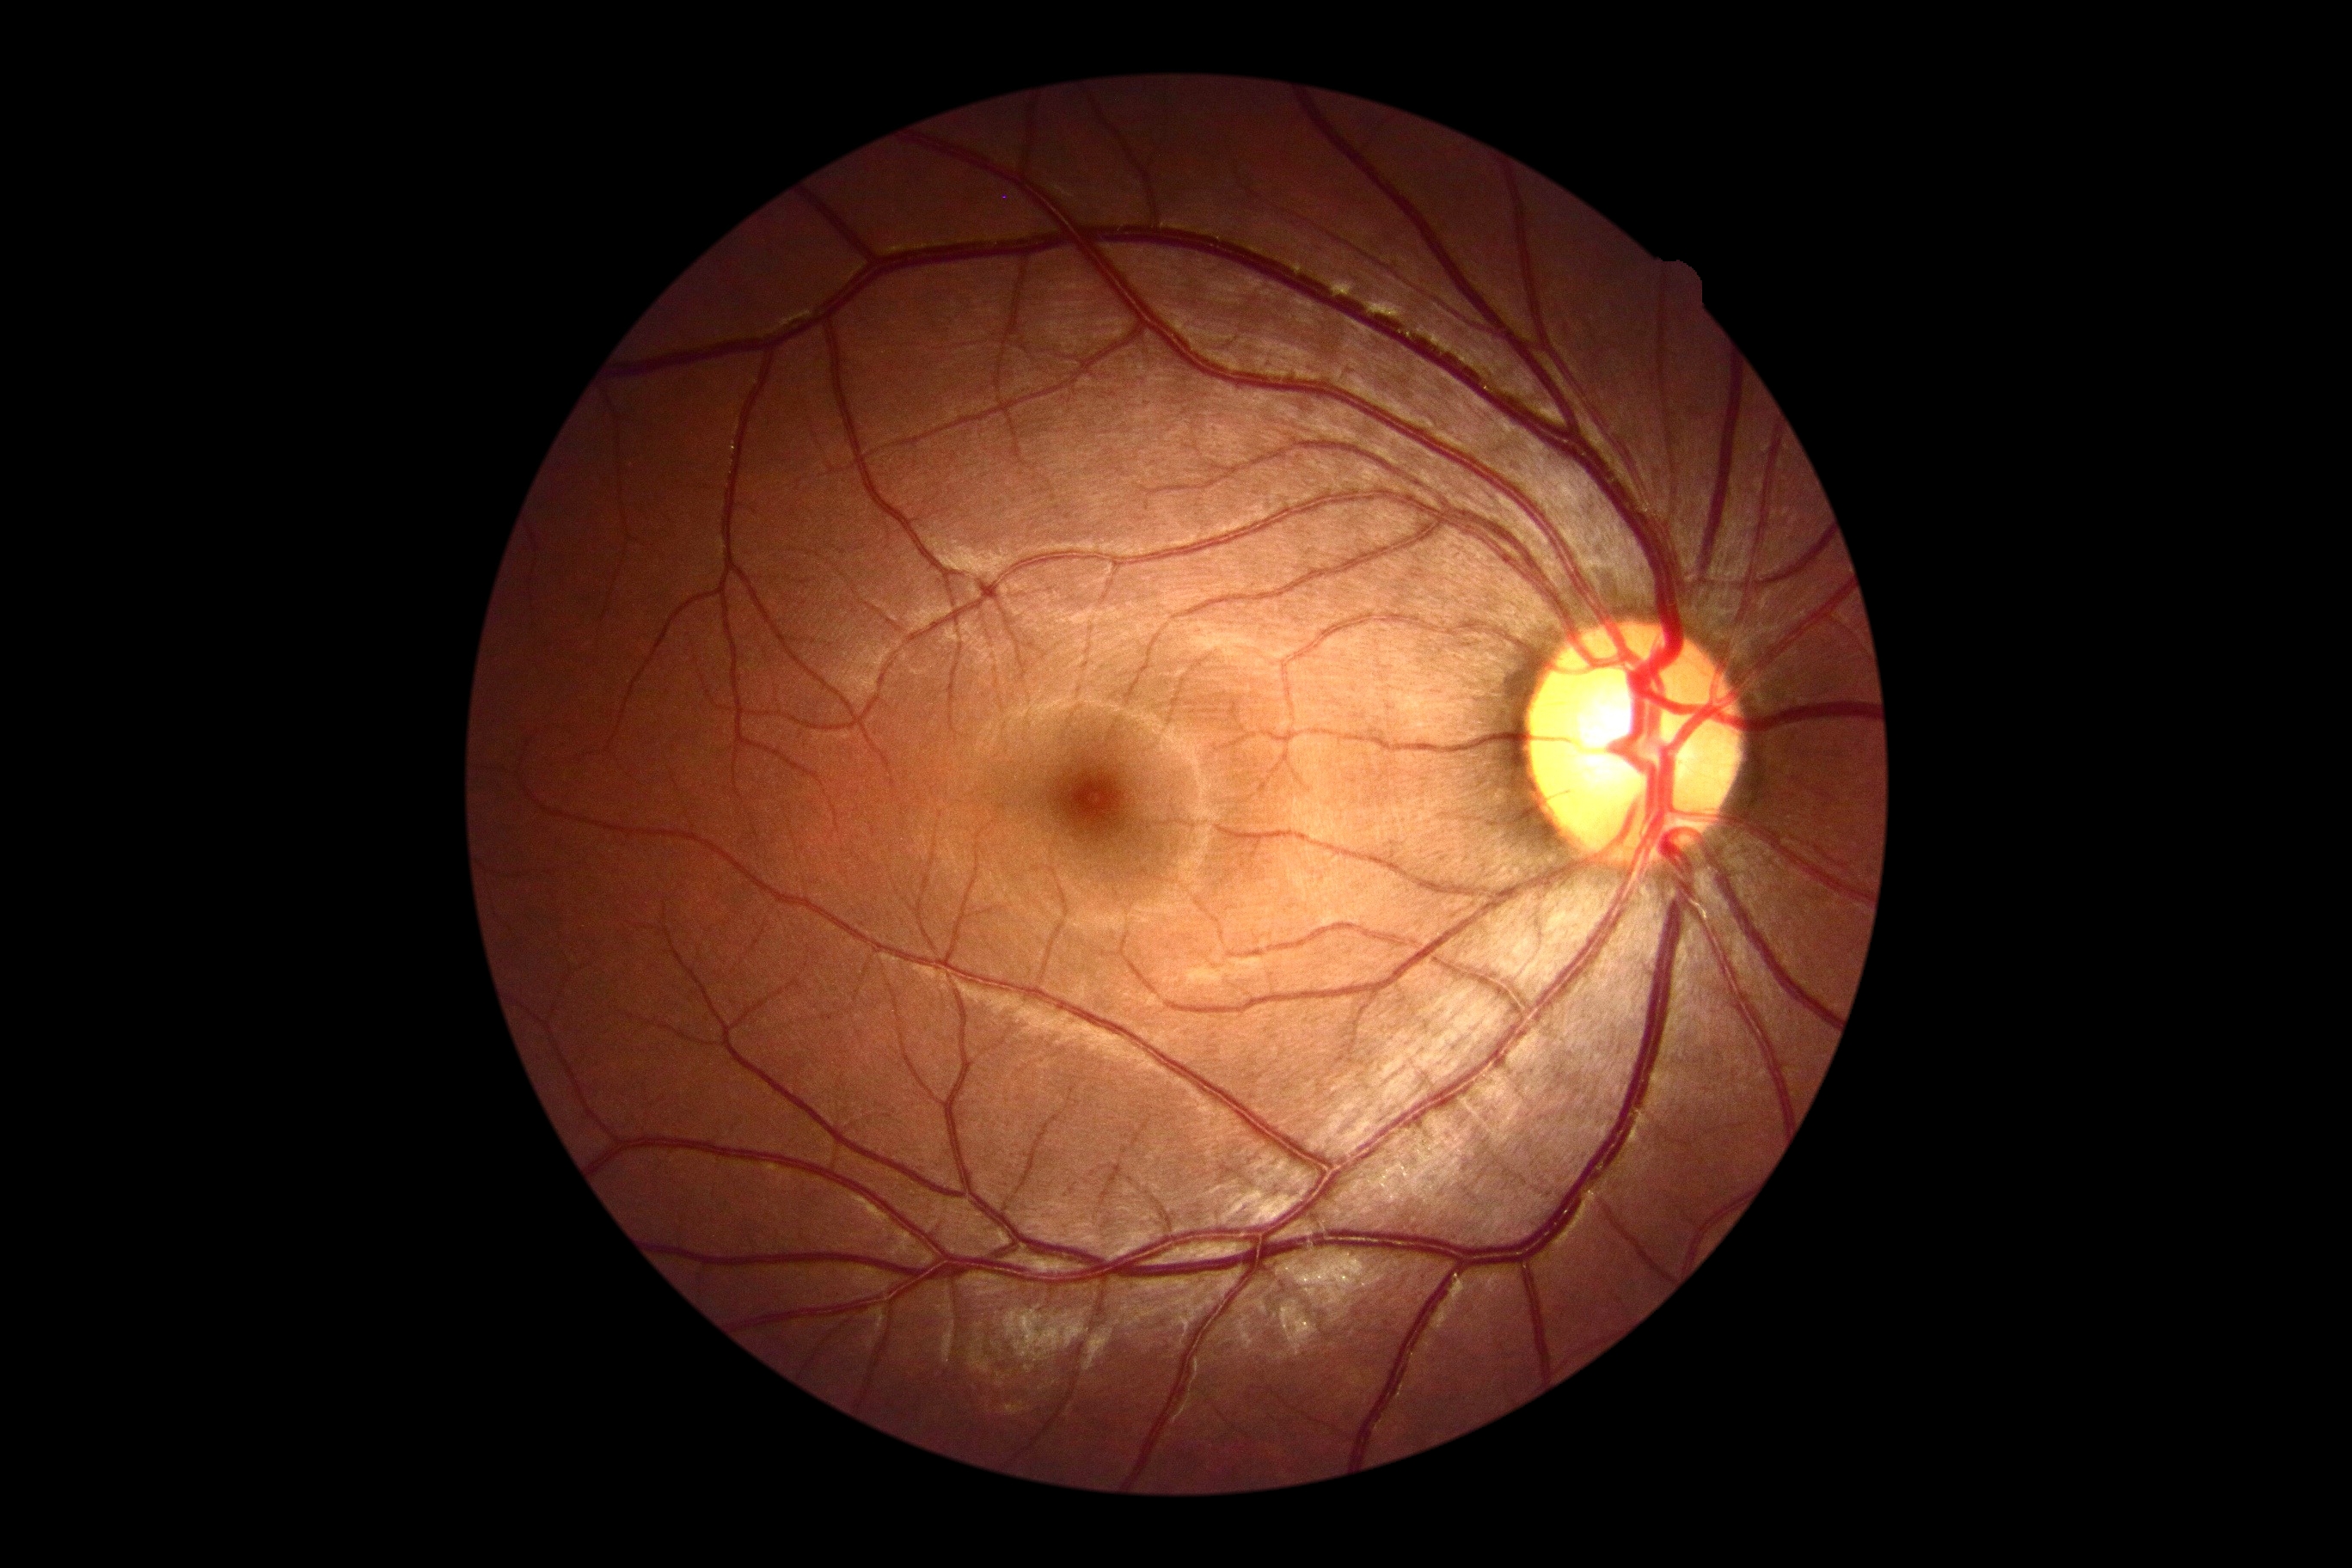
DR impression: negative for DR; DR grade: no apparent diabetic retinopathy (0).